Wide-field fundus photograph from neonatal ROP screening: 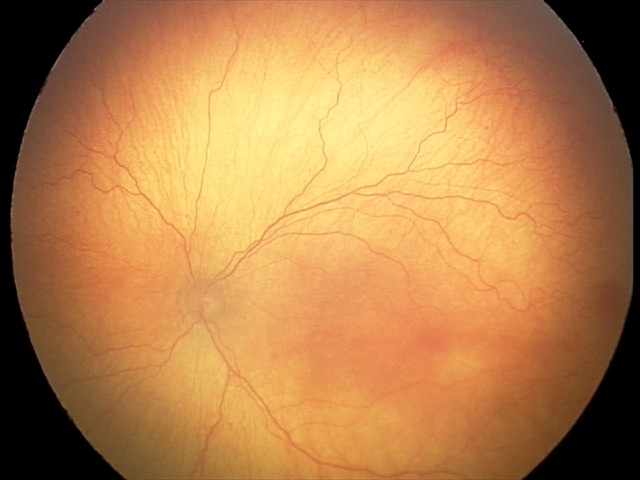
From an examination with diagnosis of aggressive retinopathy of prematurity (A-ROP).
Plus disease present.